Nidek AFC-330:
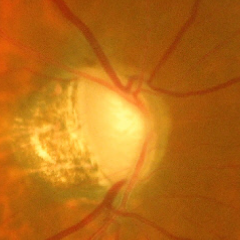
There is evidence of advanced glaucomatous optic neuropathy.